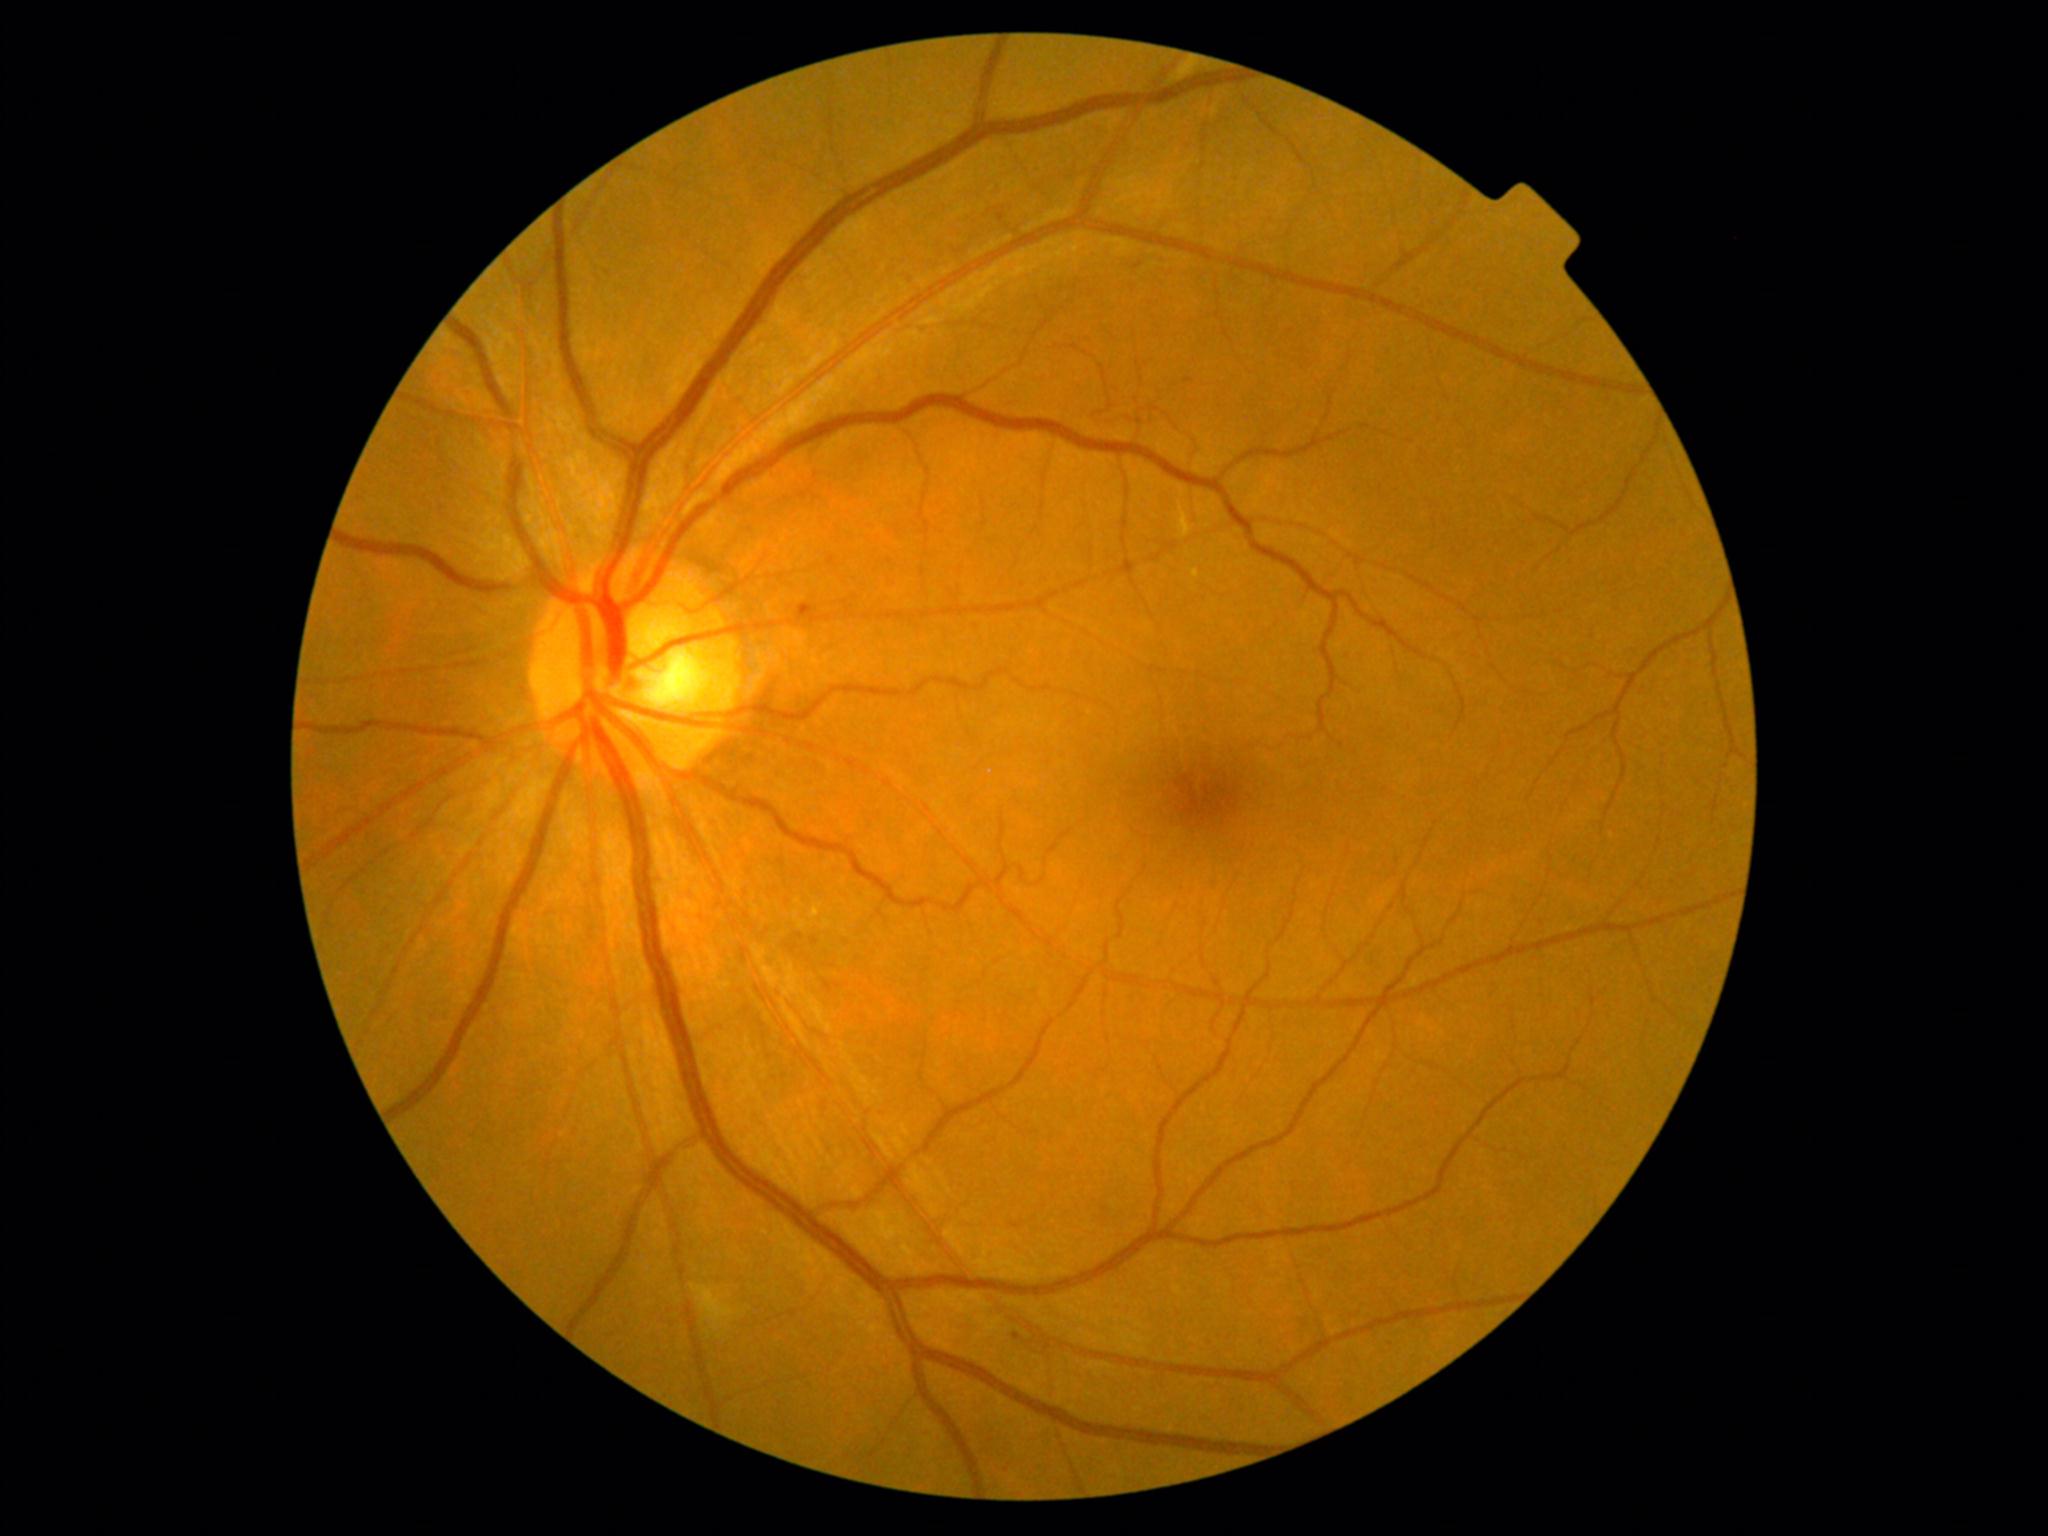 DR severity@moderate NPDR (grade 2).